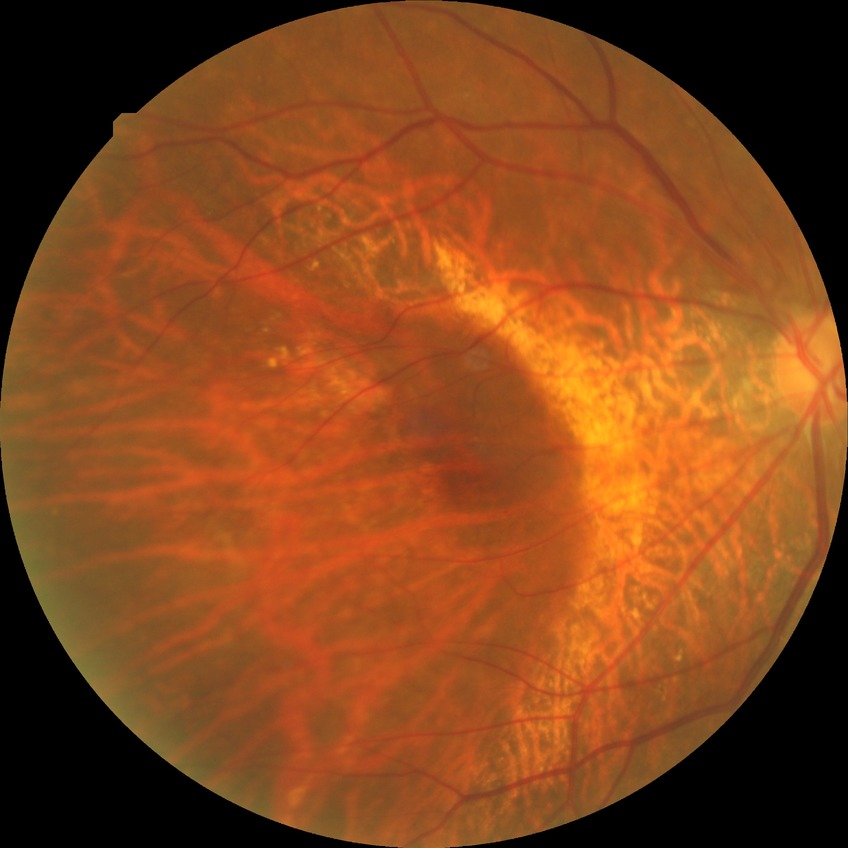

Diabetic retinopathy (DR) is NDR (no diabetic retinopathy).